Infant wide-field retinal image.
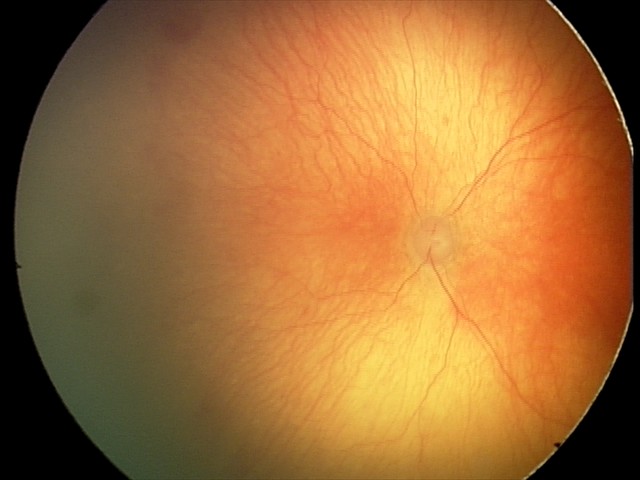 Examination diagnosed as aggressive retinopathy of prematurity (A-ROP).
Plus disease present.